Modified Davis grading · fundus photo:
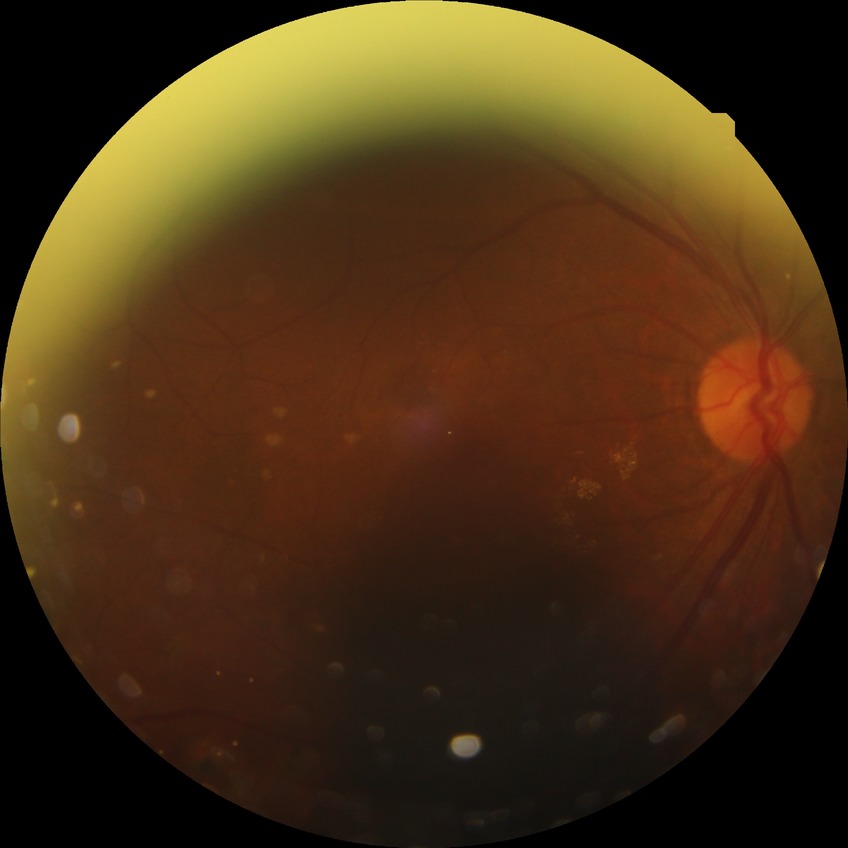 DR: PDR.